Disc-centered field, image size 240x240:
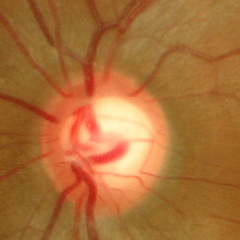

Assessment = no evidence of glaucoma.